45 degree fundus photograph:
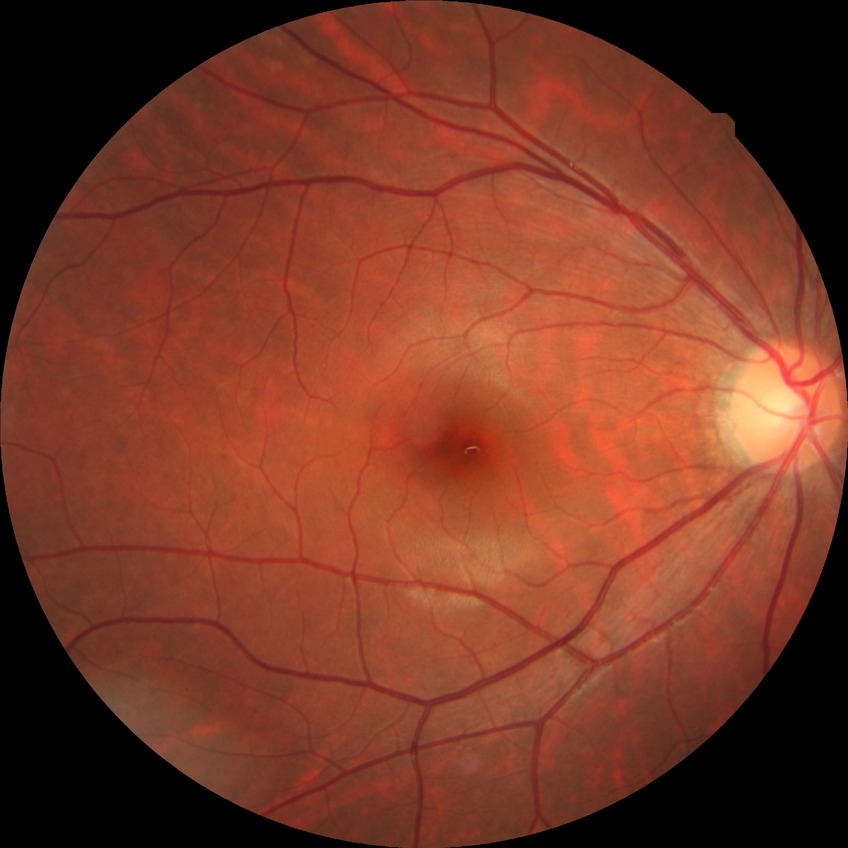

Diabetic retinopathy (DR) is no diabetic retinopathy (NDR).